Fundus photo
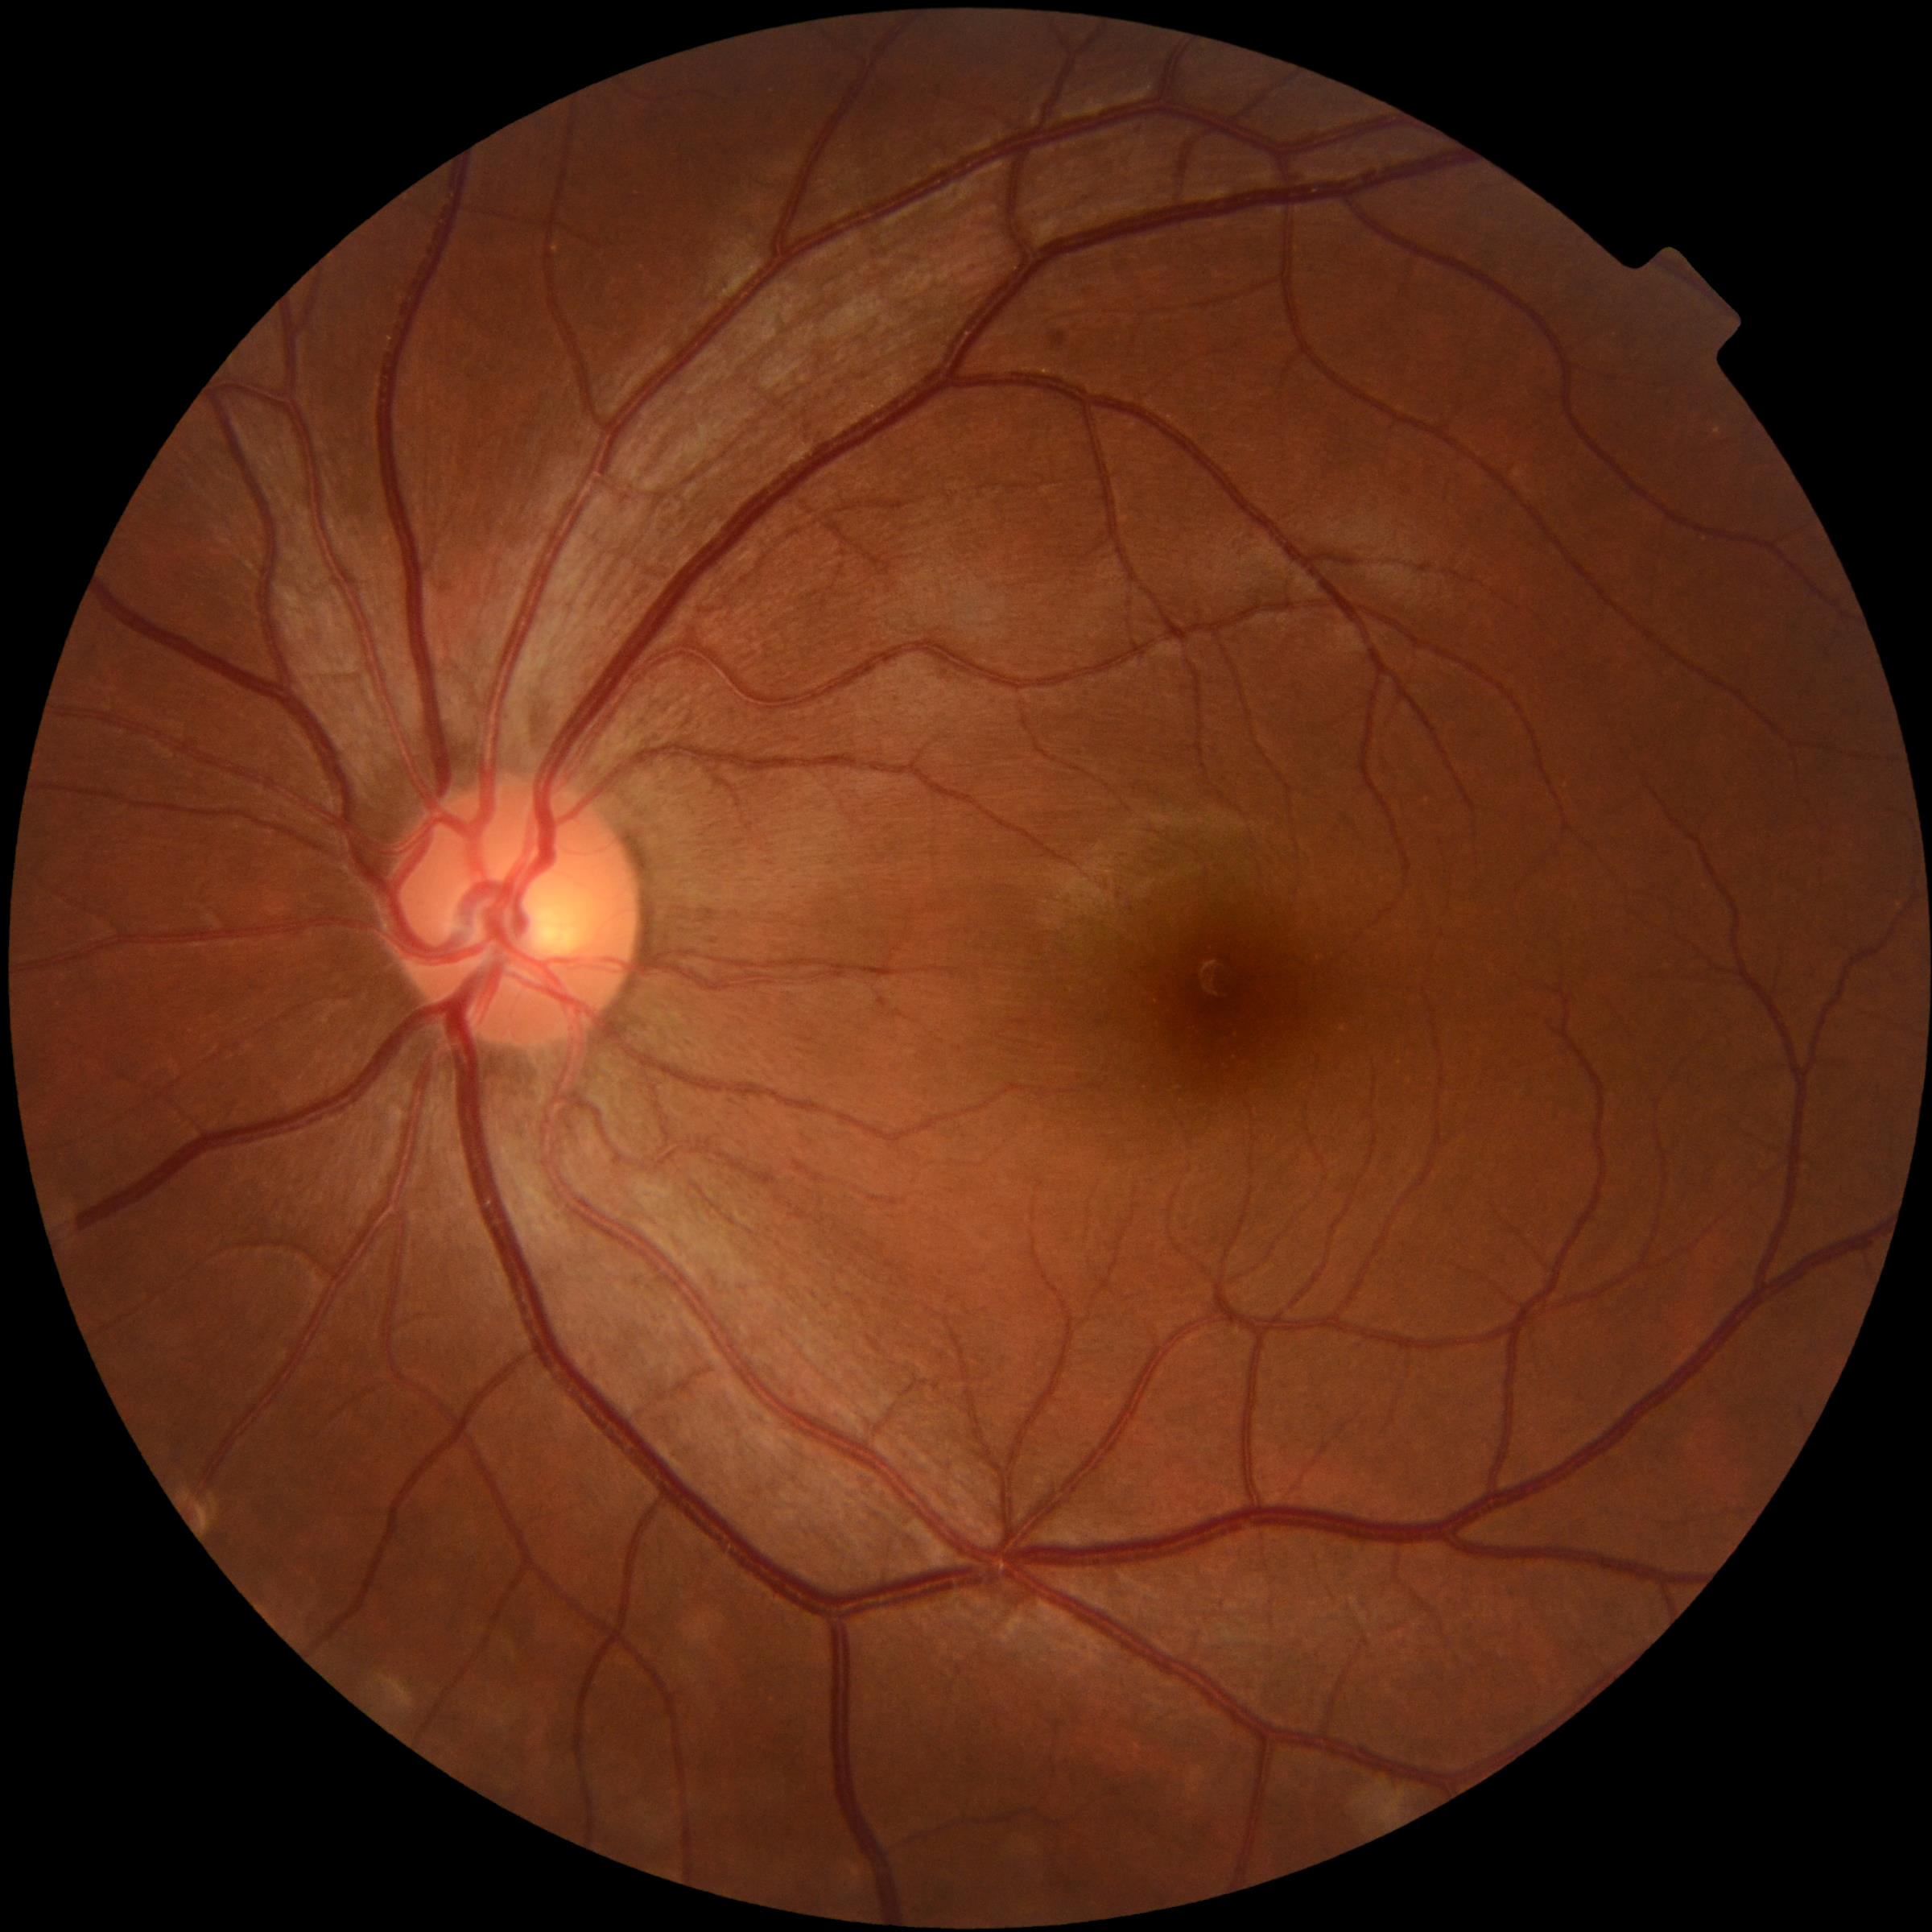

Diabetic retinopathy (DR) is 0.
No DR findings.